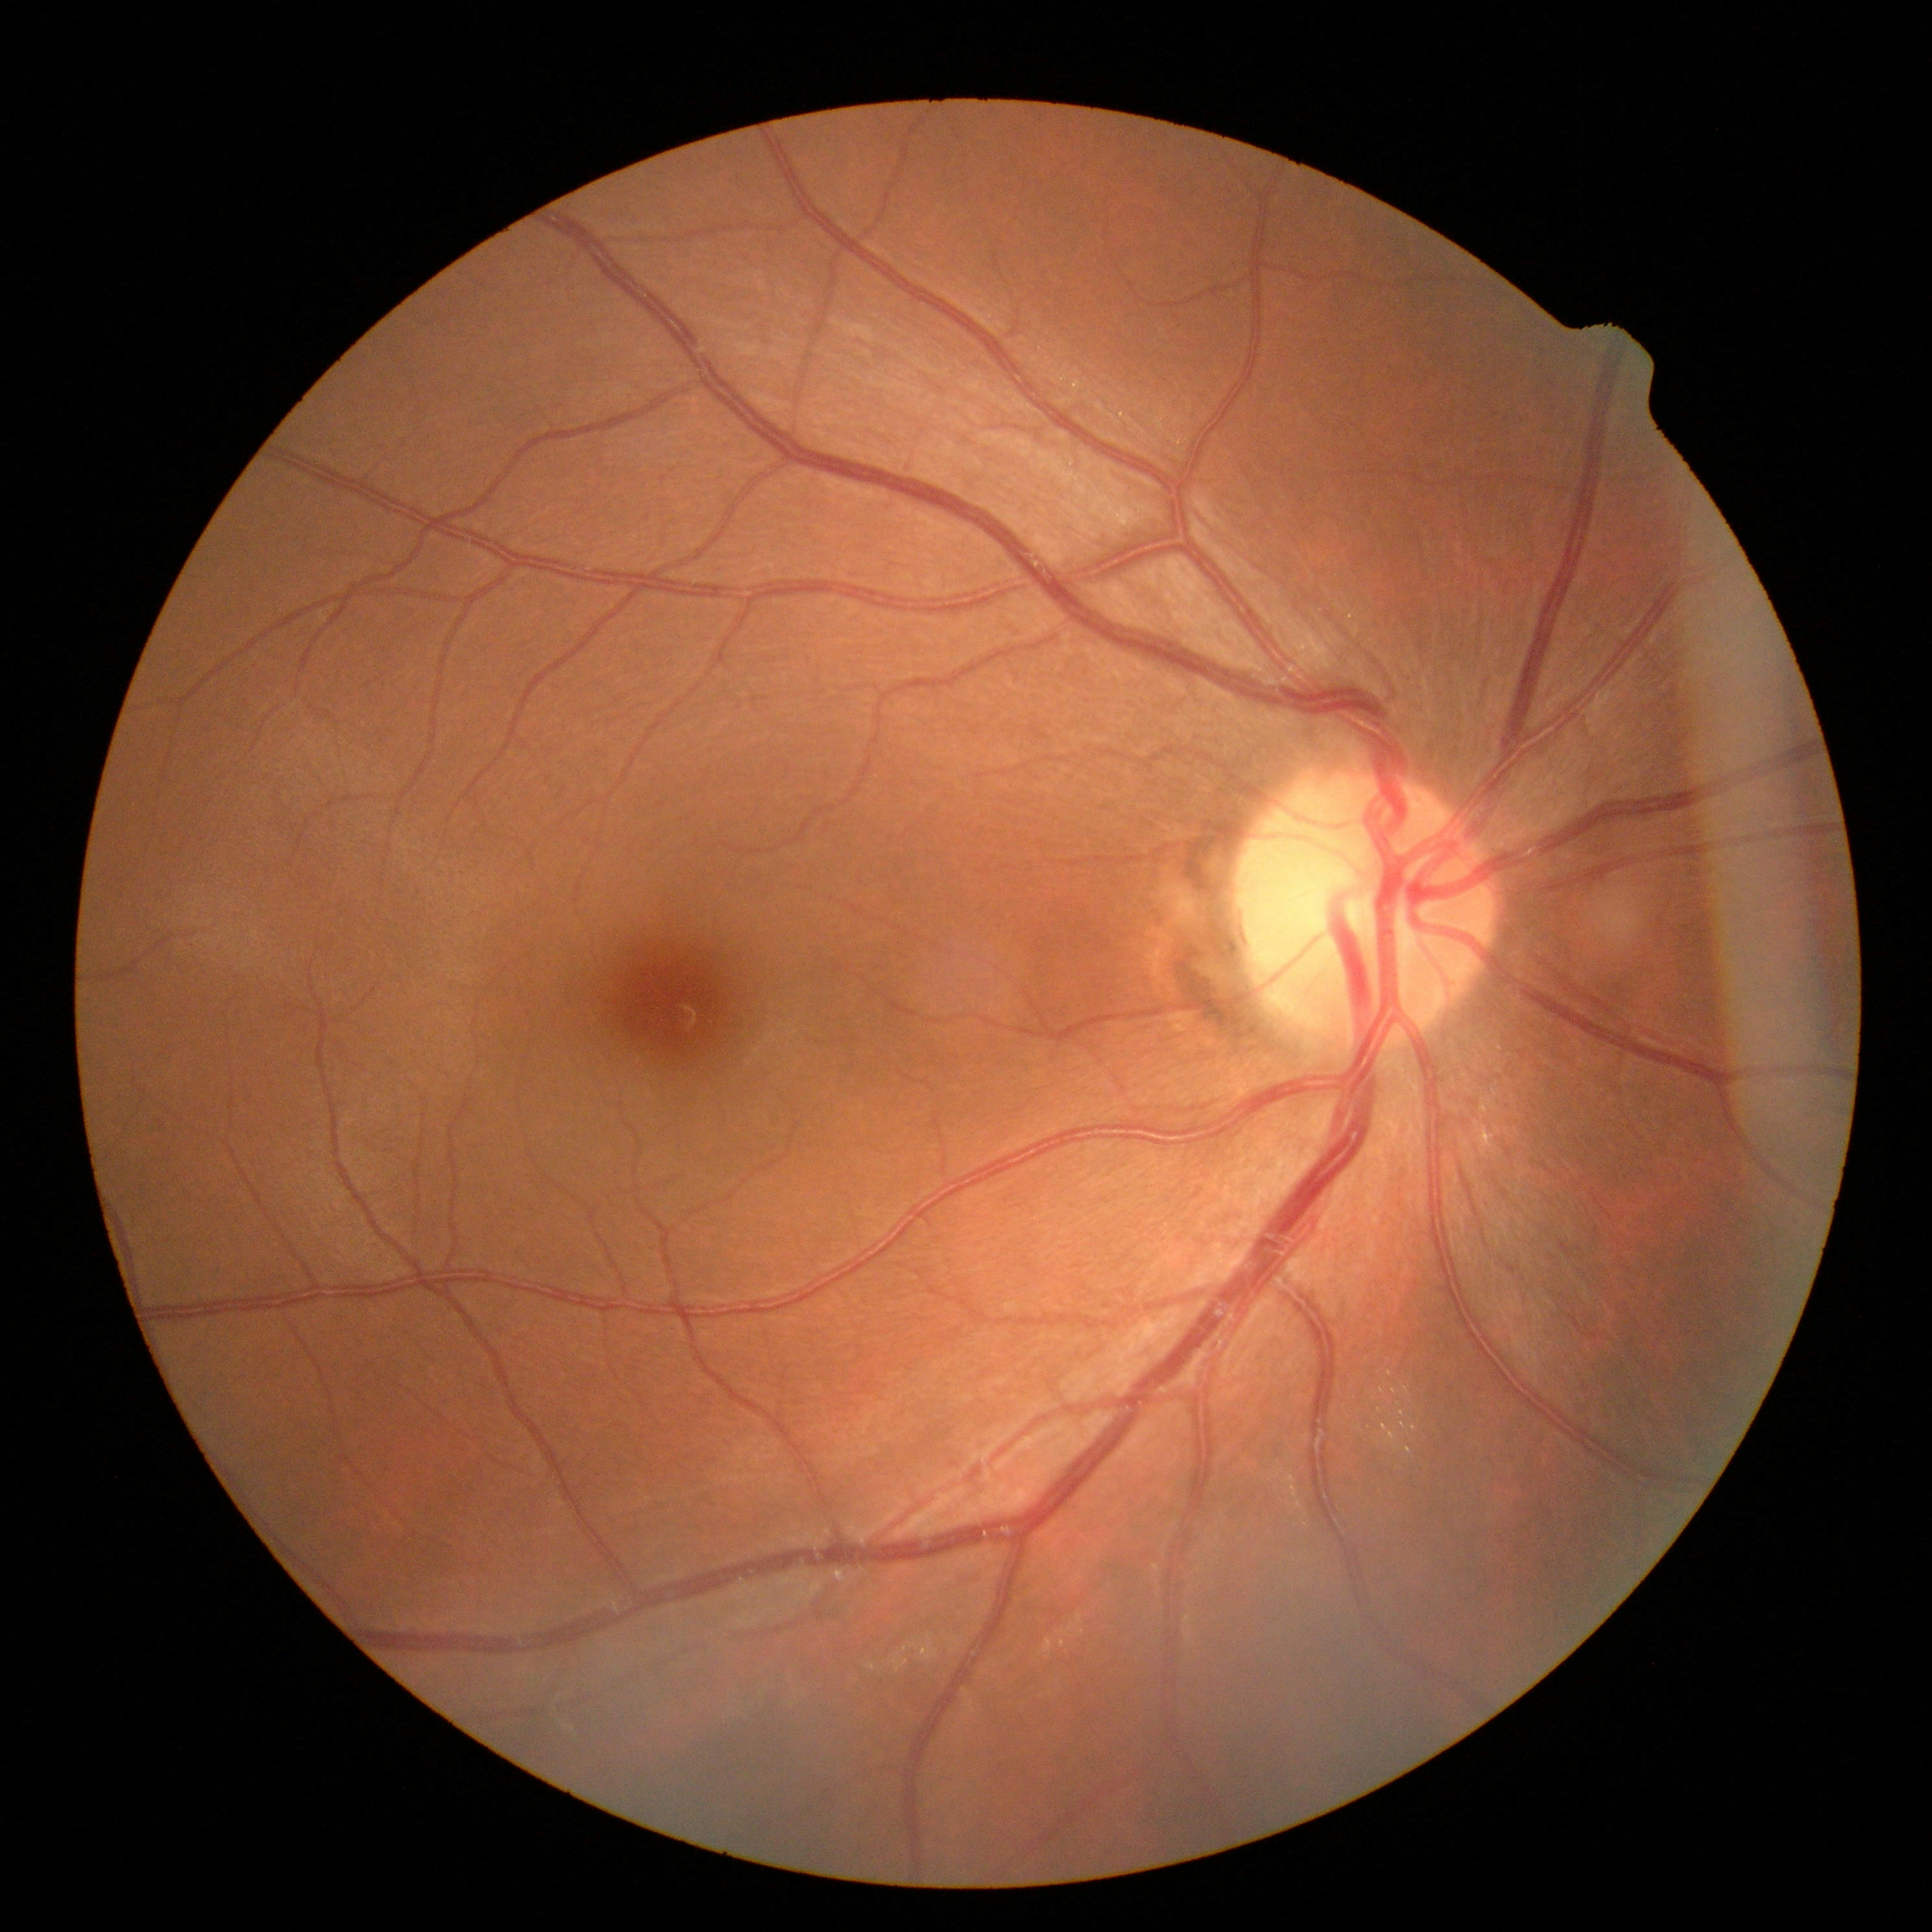

No signs of diabetic retinopathy.
Diabetic retinopathy (DR): 0.